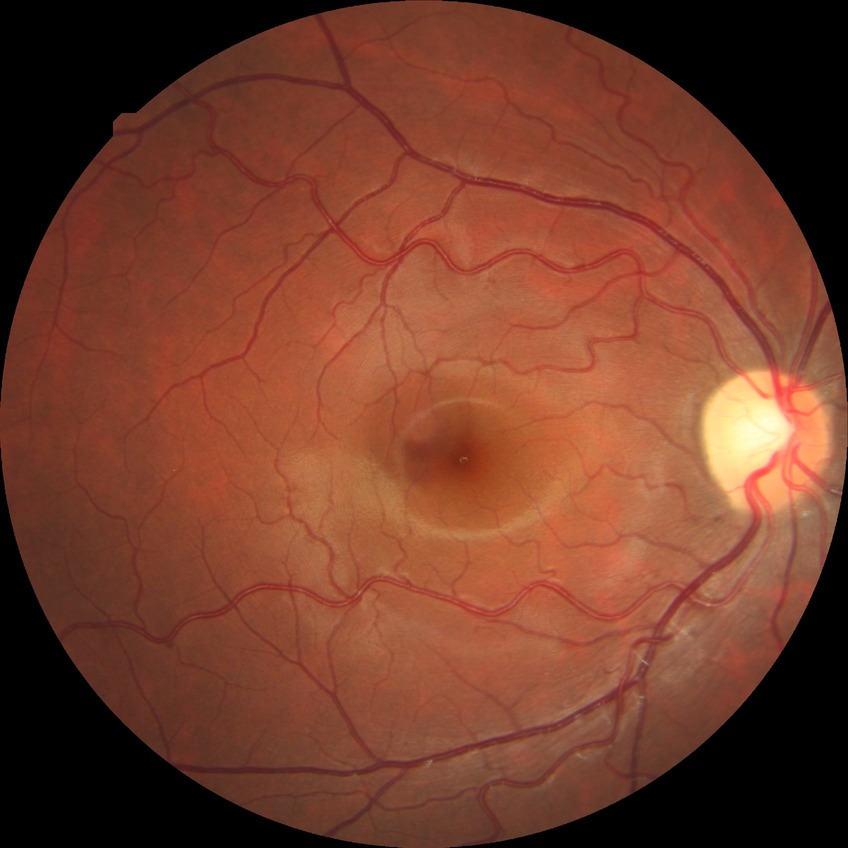 Modified Davis classification: no diabetic retinopathy.